Wide-field fundus image from infant ROP screening; captured with the Clarity RetCam 3 (130° field of view).
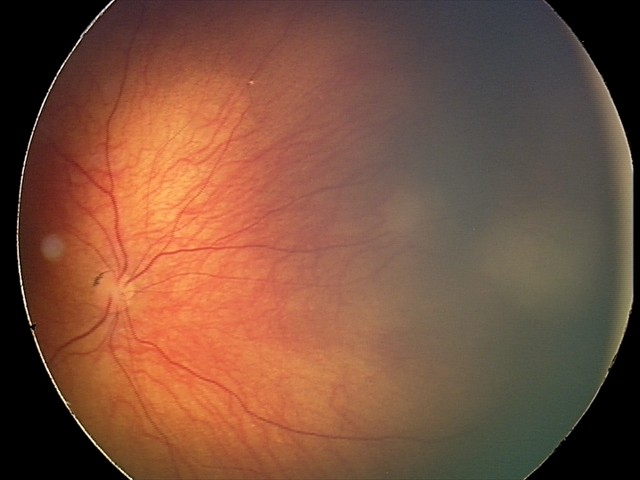 Impression: retinal astrocytic hamartoma.